45° FOV: 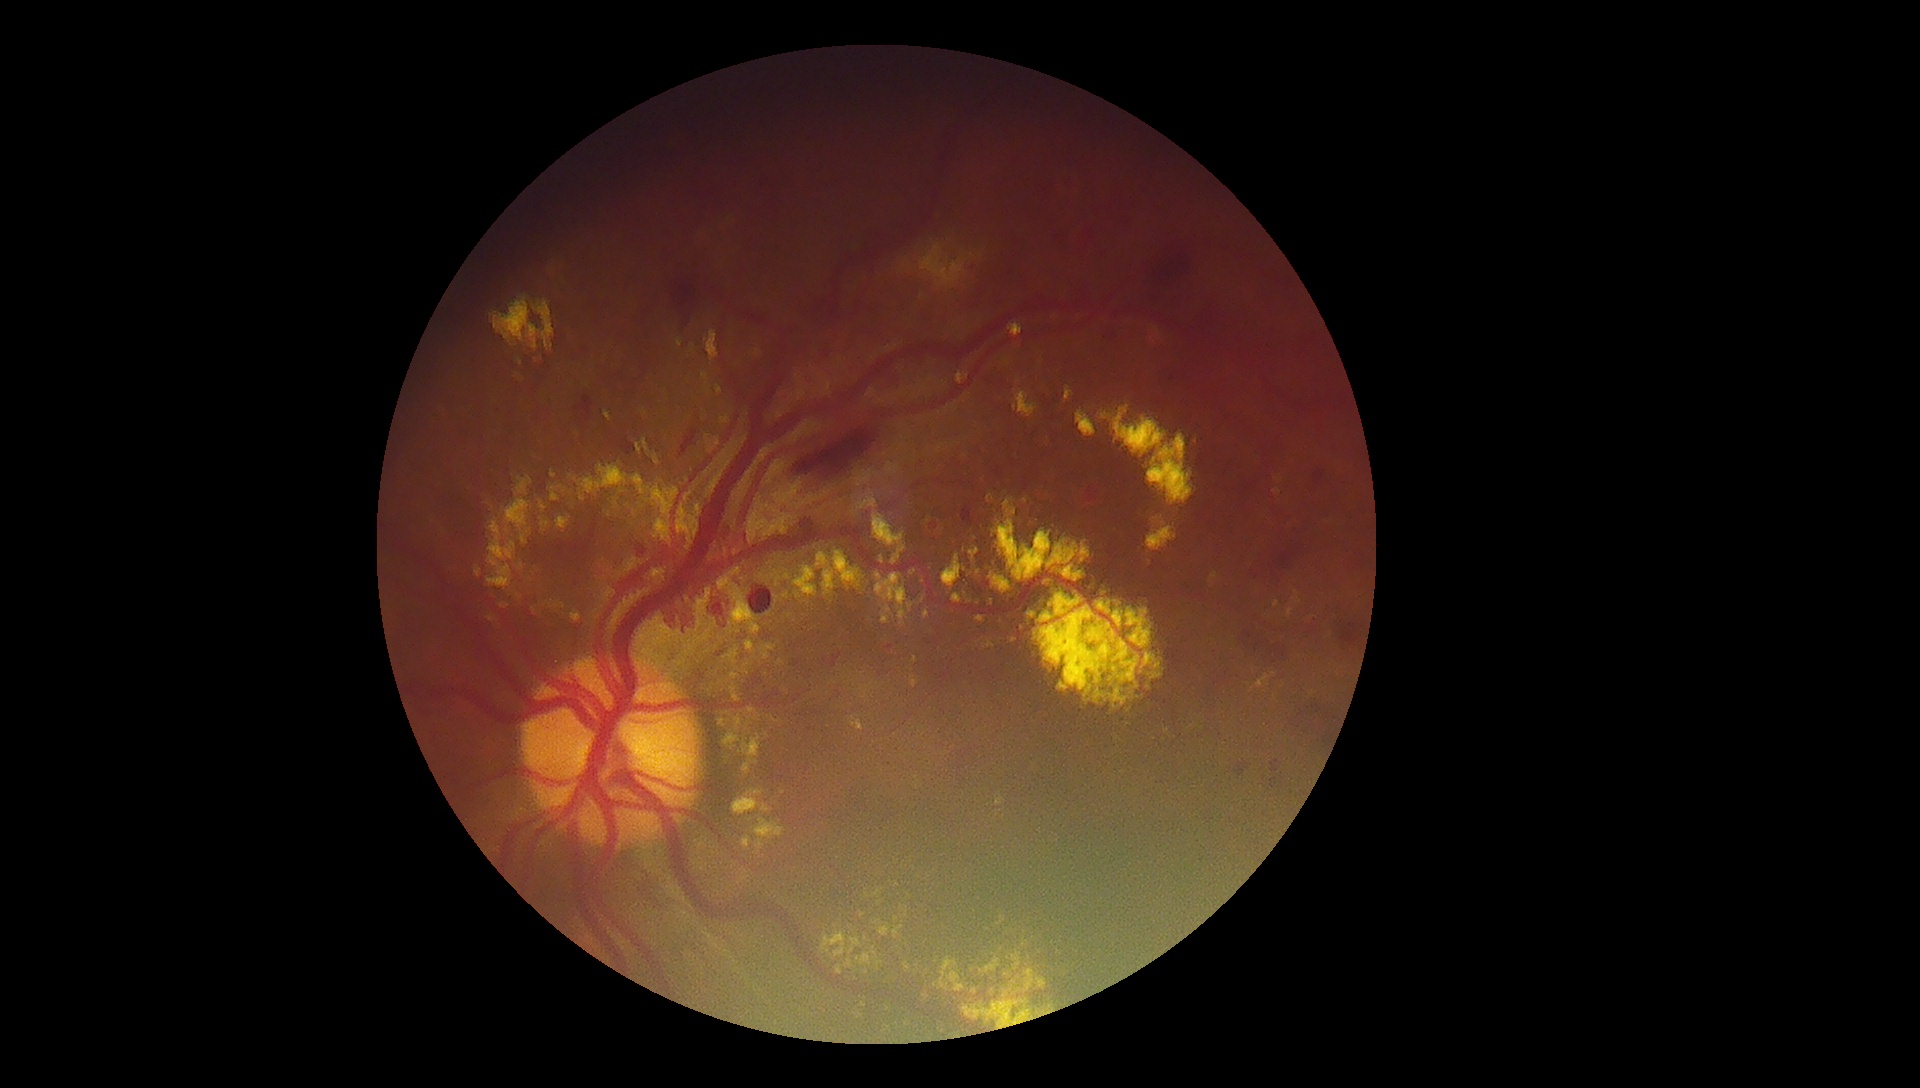

Retinopathy grade: 4; proliferative diabetic retinopathy
Selected lesions:
hard exudates (partial) = [x1=1144, y1=509, x2=1178, y2=564]; [x1=541, y1=522, x2=550, y2=528]; [x1=823, y1=569, x2=835, y2=596]; [x1=696, y1=617, x2=704, y2=633]; [x1=486, y1=614, x2=496, y2=623]; [x1=881, y1=557, x2=884, y2=565]; [x1=1014, y1=390, x2=1038, y2=418]; [x1=1153, y1=327, x2=1160, y2=336]; [x1=732, y1=789, x2=770, y2=816]; [x1=730, y1=683, x2=742, y2=702]; [x1=1065, y1=386, x2=1075, y2=403]; [x1=835, y1=966, x2=843, y2=976]
Smaller hard exudates around Point(906, 915); Point(879, 577); Point(907, 1024); Point(520, 596); Point(918, 966); Point(1273, 675)